2212 x 1659 pixels, fundus photo taken with a portable handheld camera.
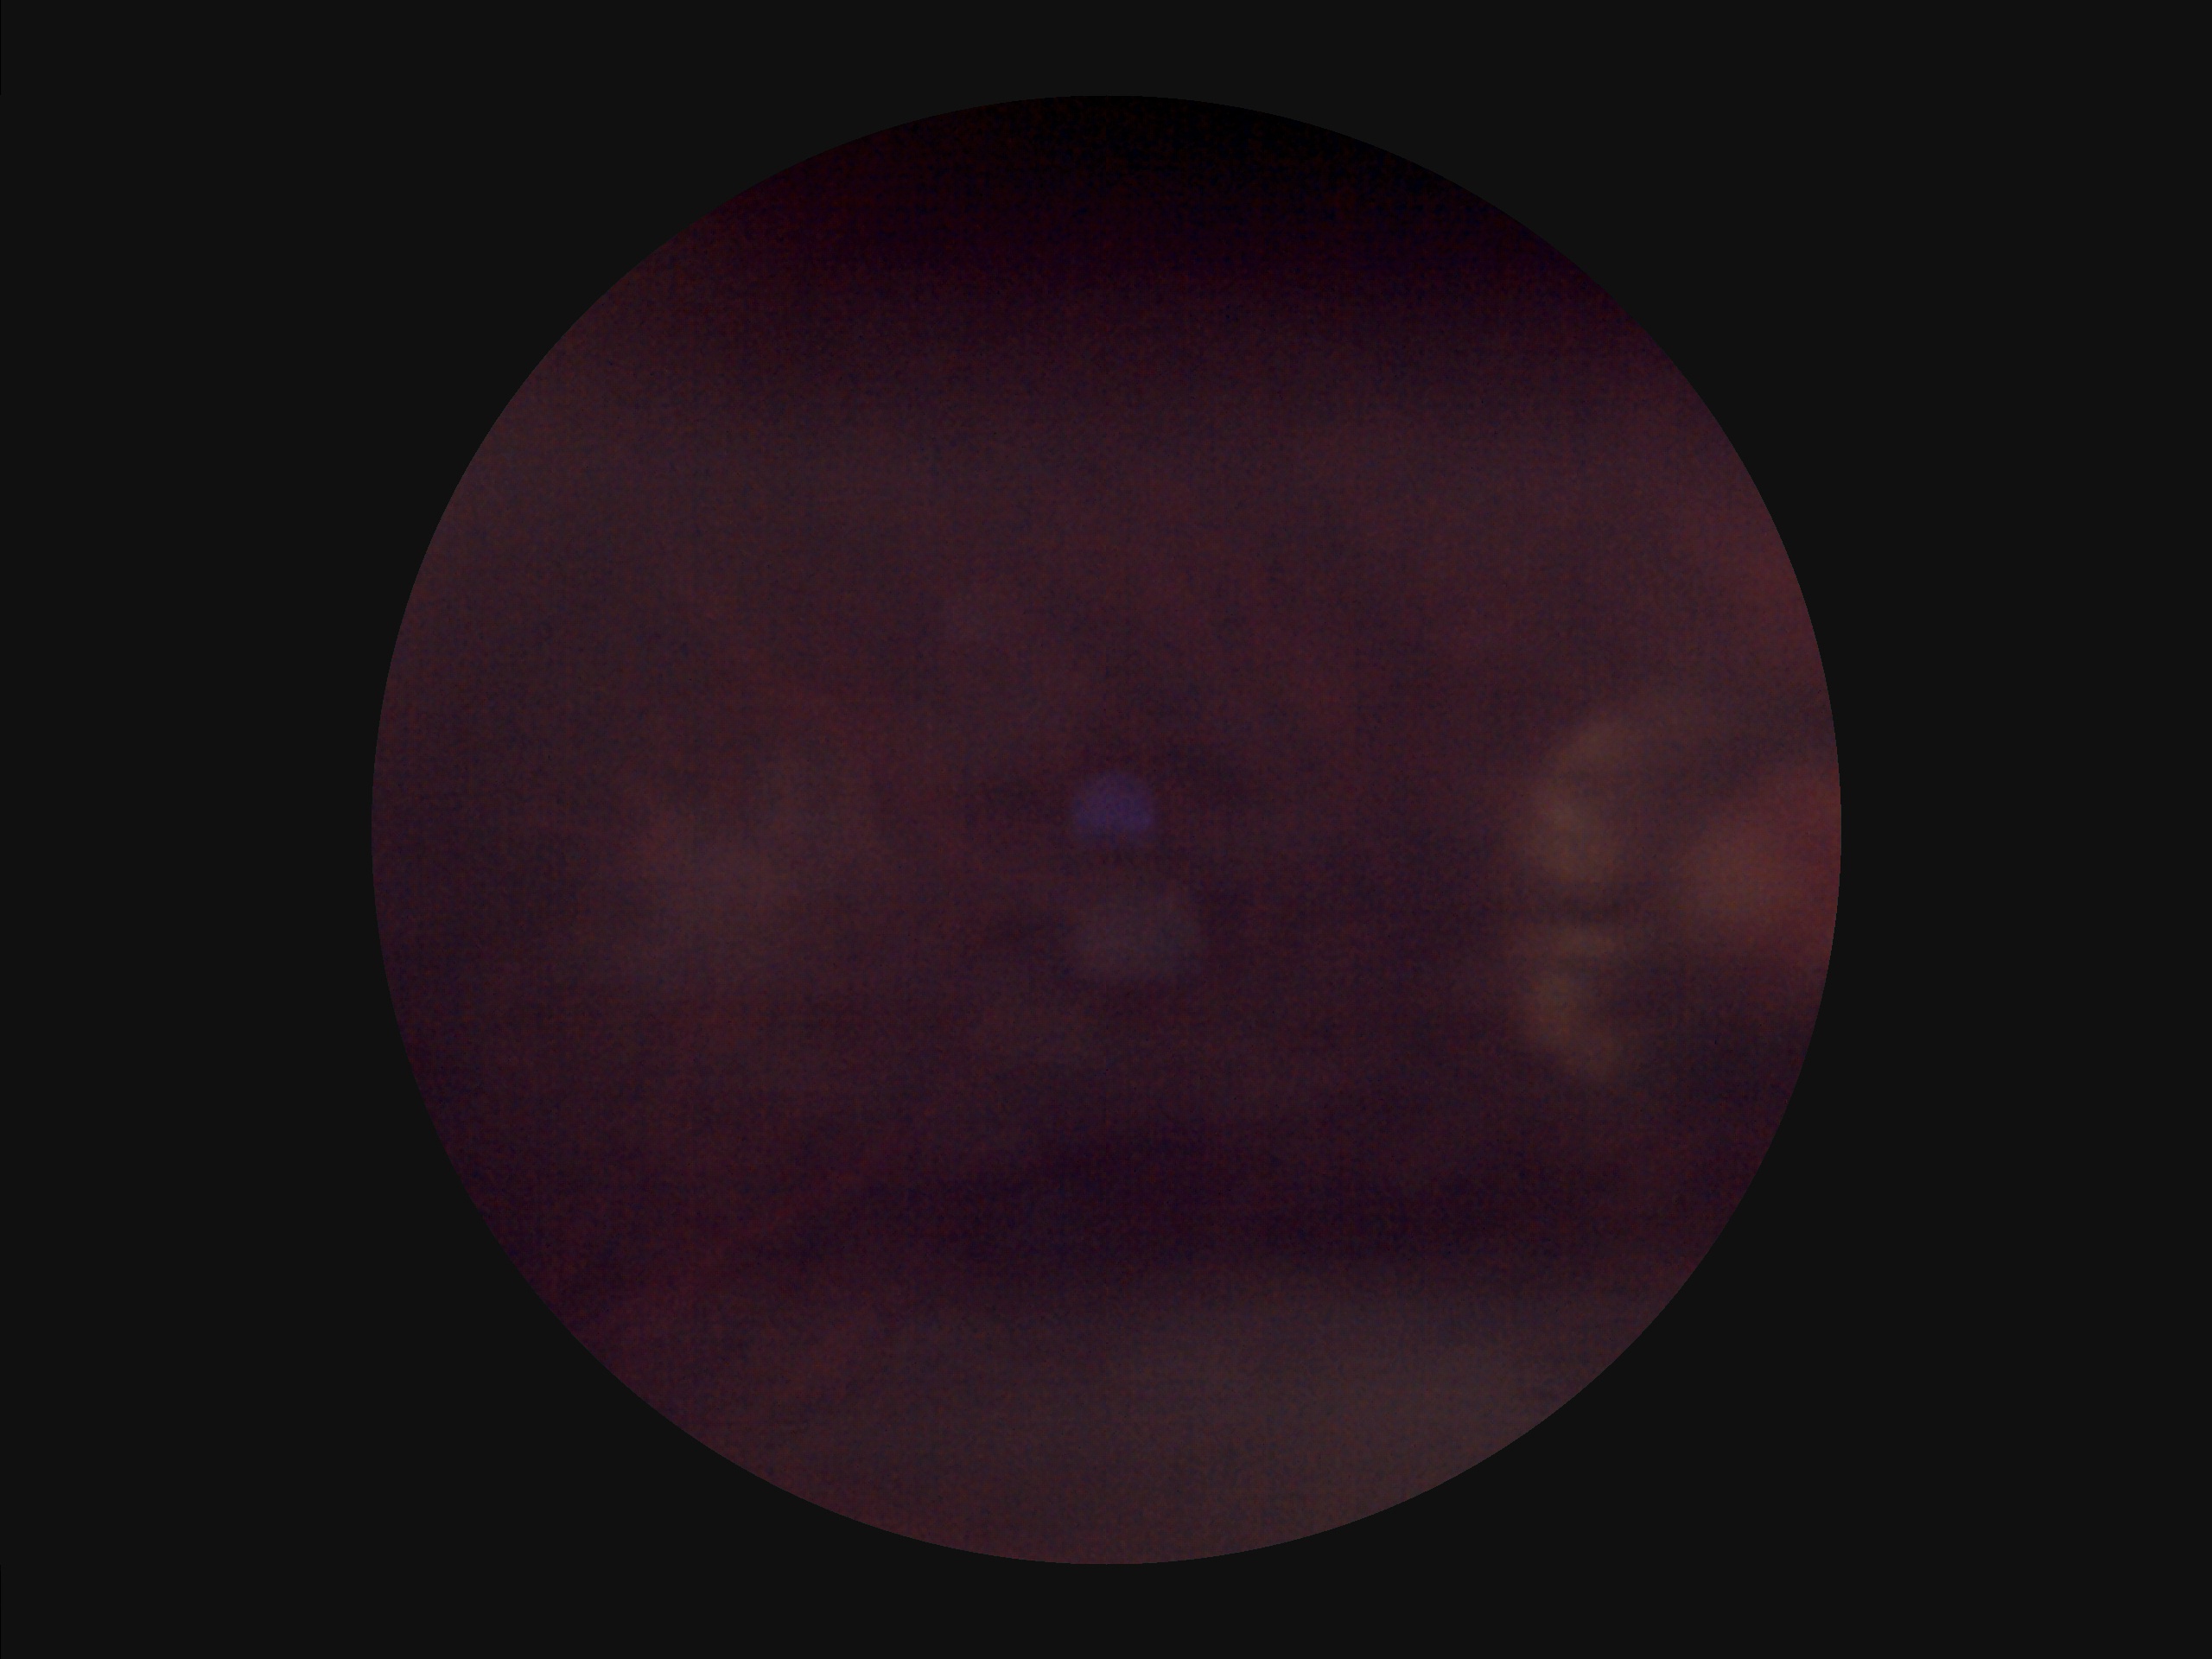
Out of focus; structures are indistinct.
Image quality is inadequate for diagnostic use.
Narrow intensity range; structures are hard to distinguish.
Poor illumination with uneven exposure.